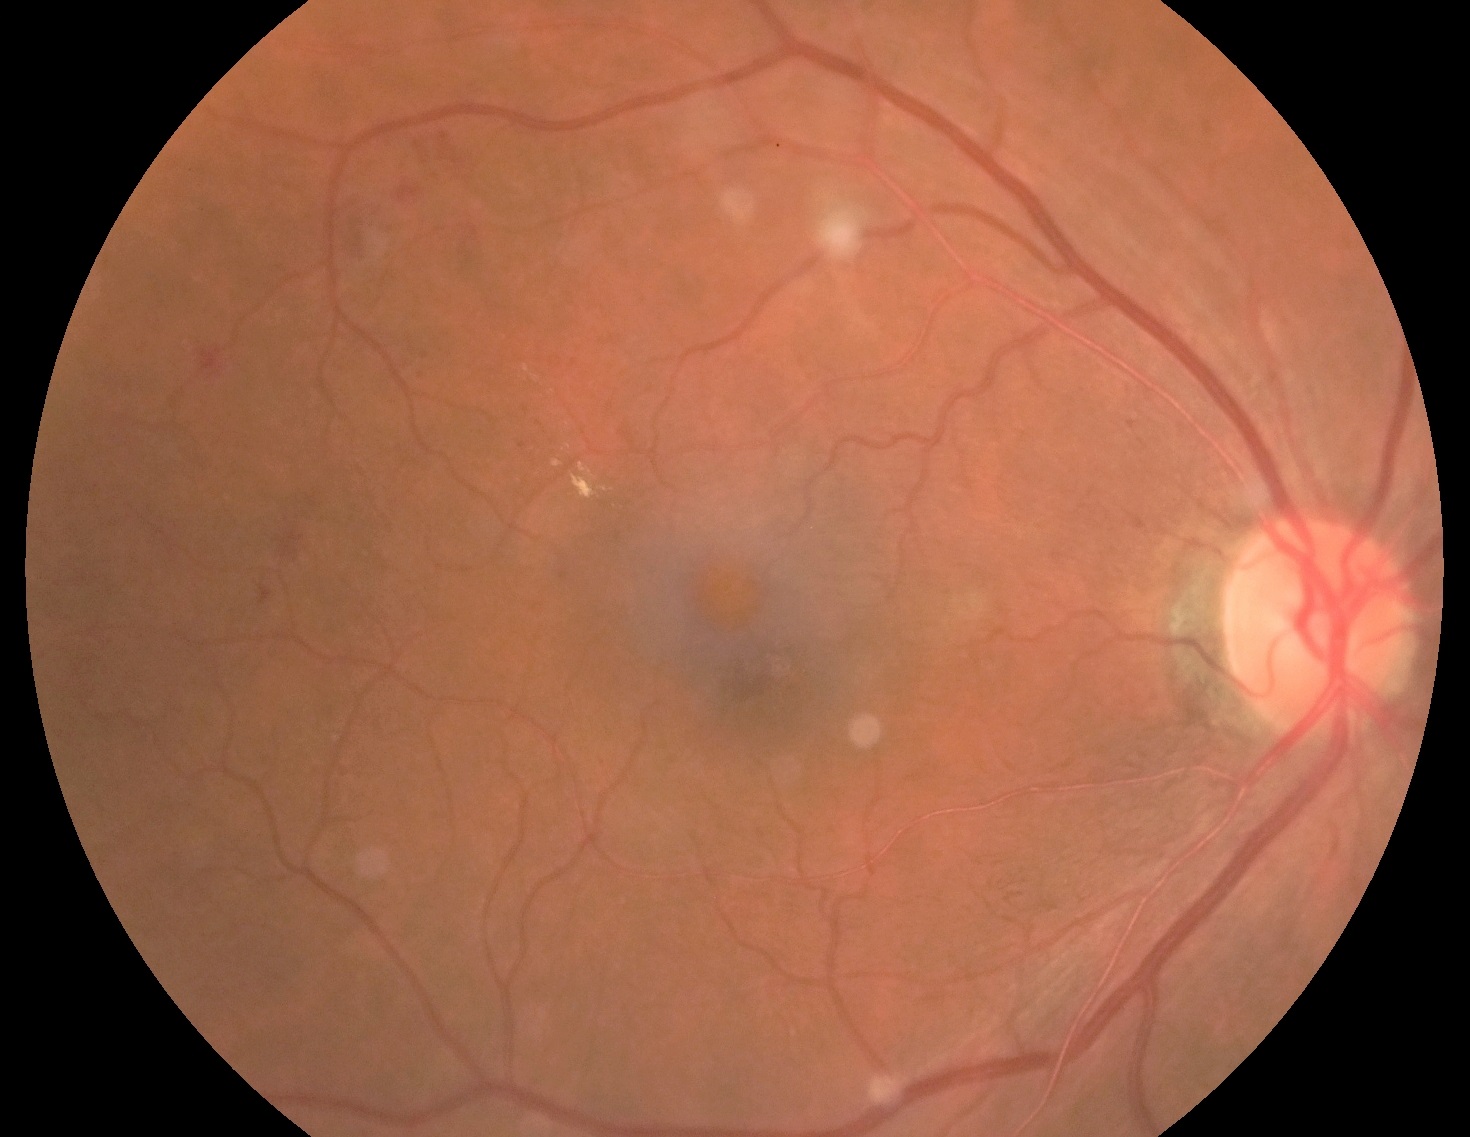
DR class: non-proliferative diabetic retinopathy, retinopathy: 2.